Fundus photo.
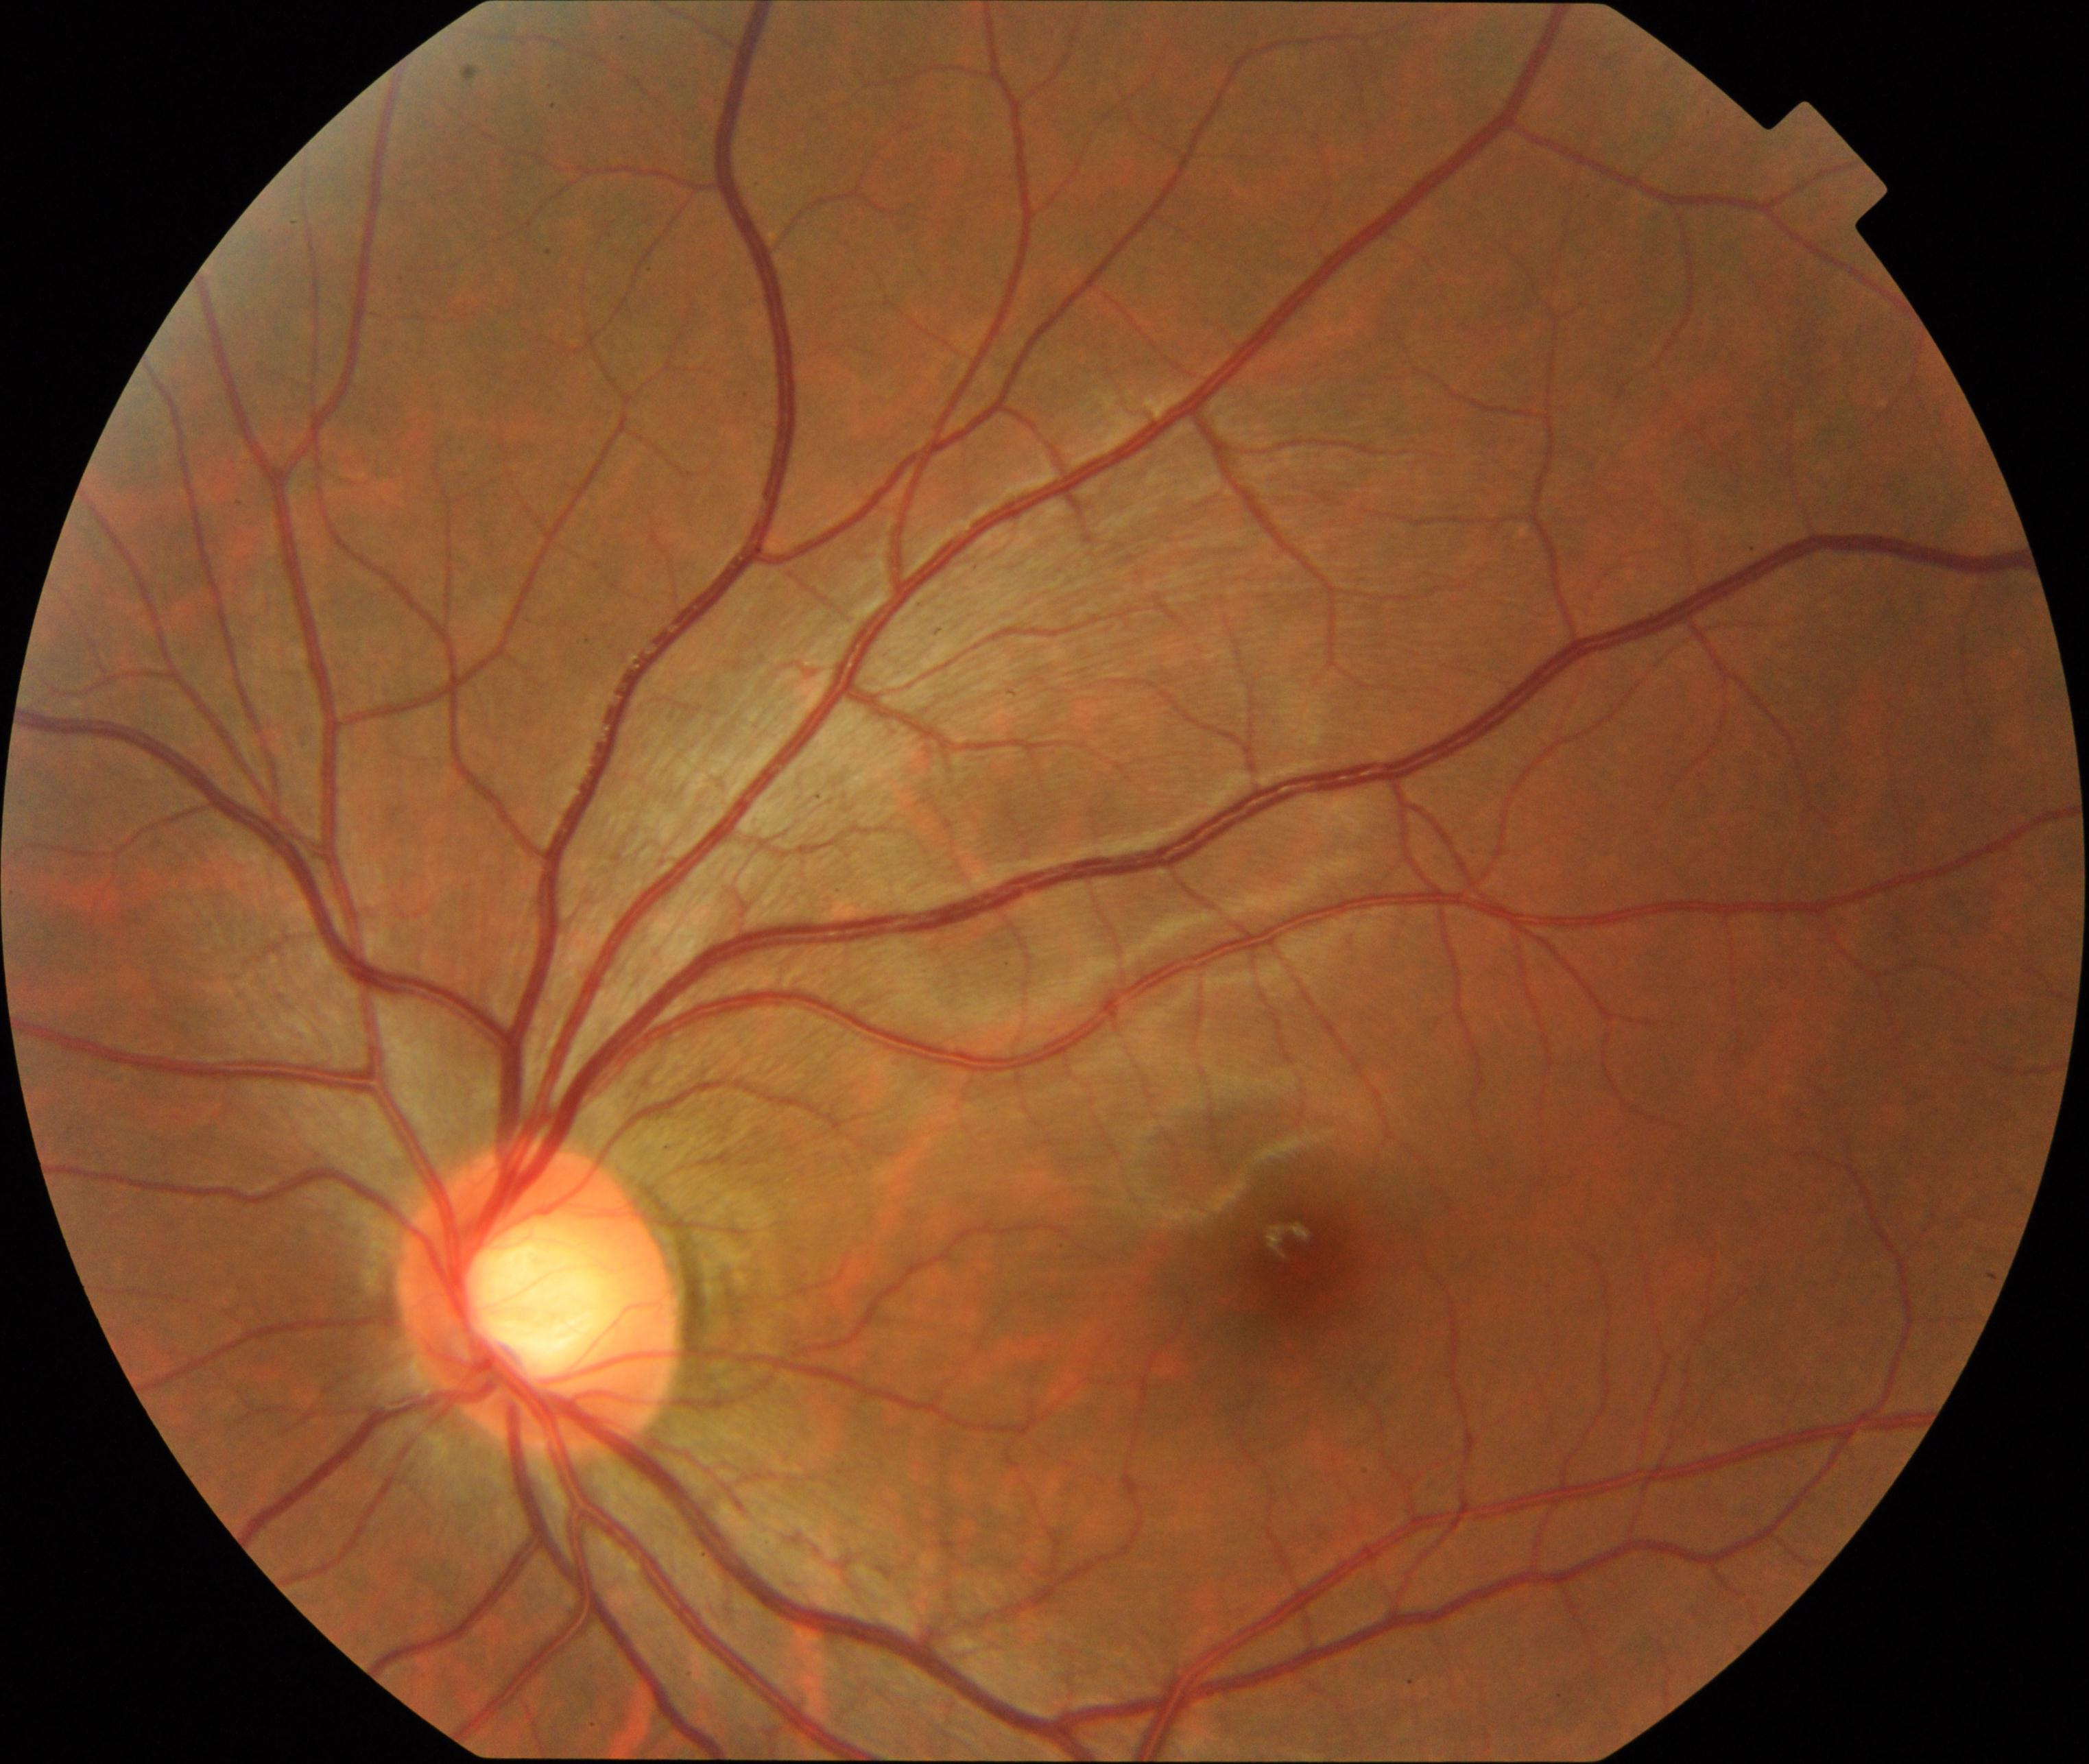
Findings: large optic cup.